45° field of view:
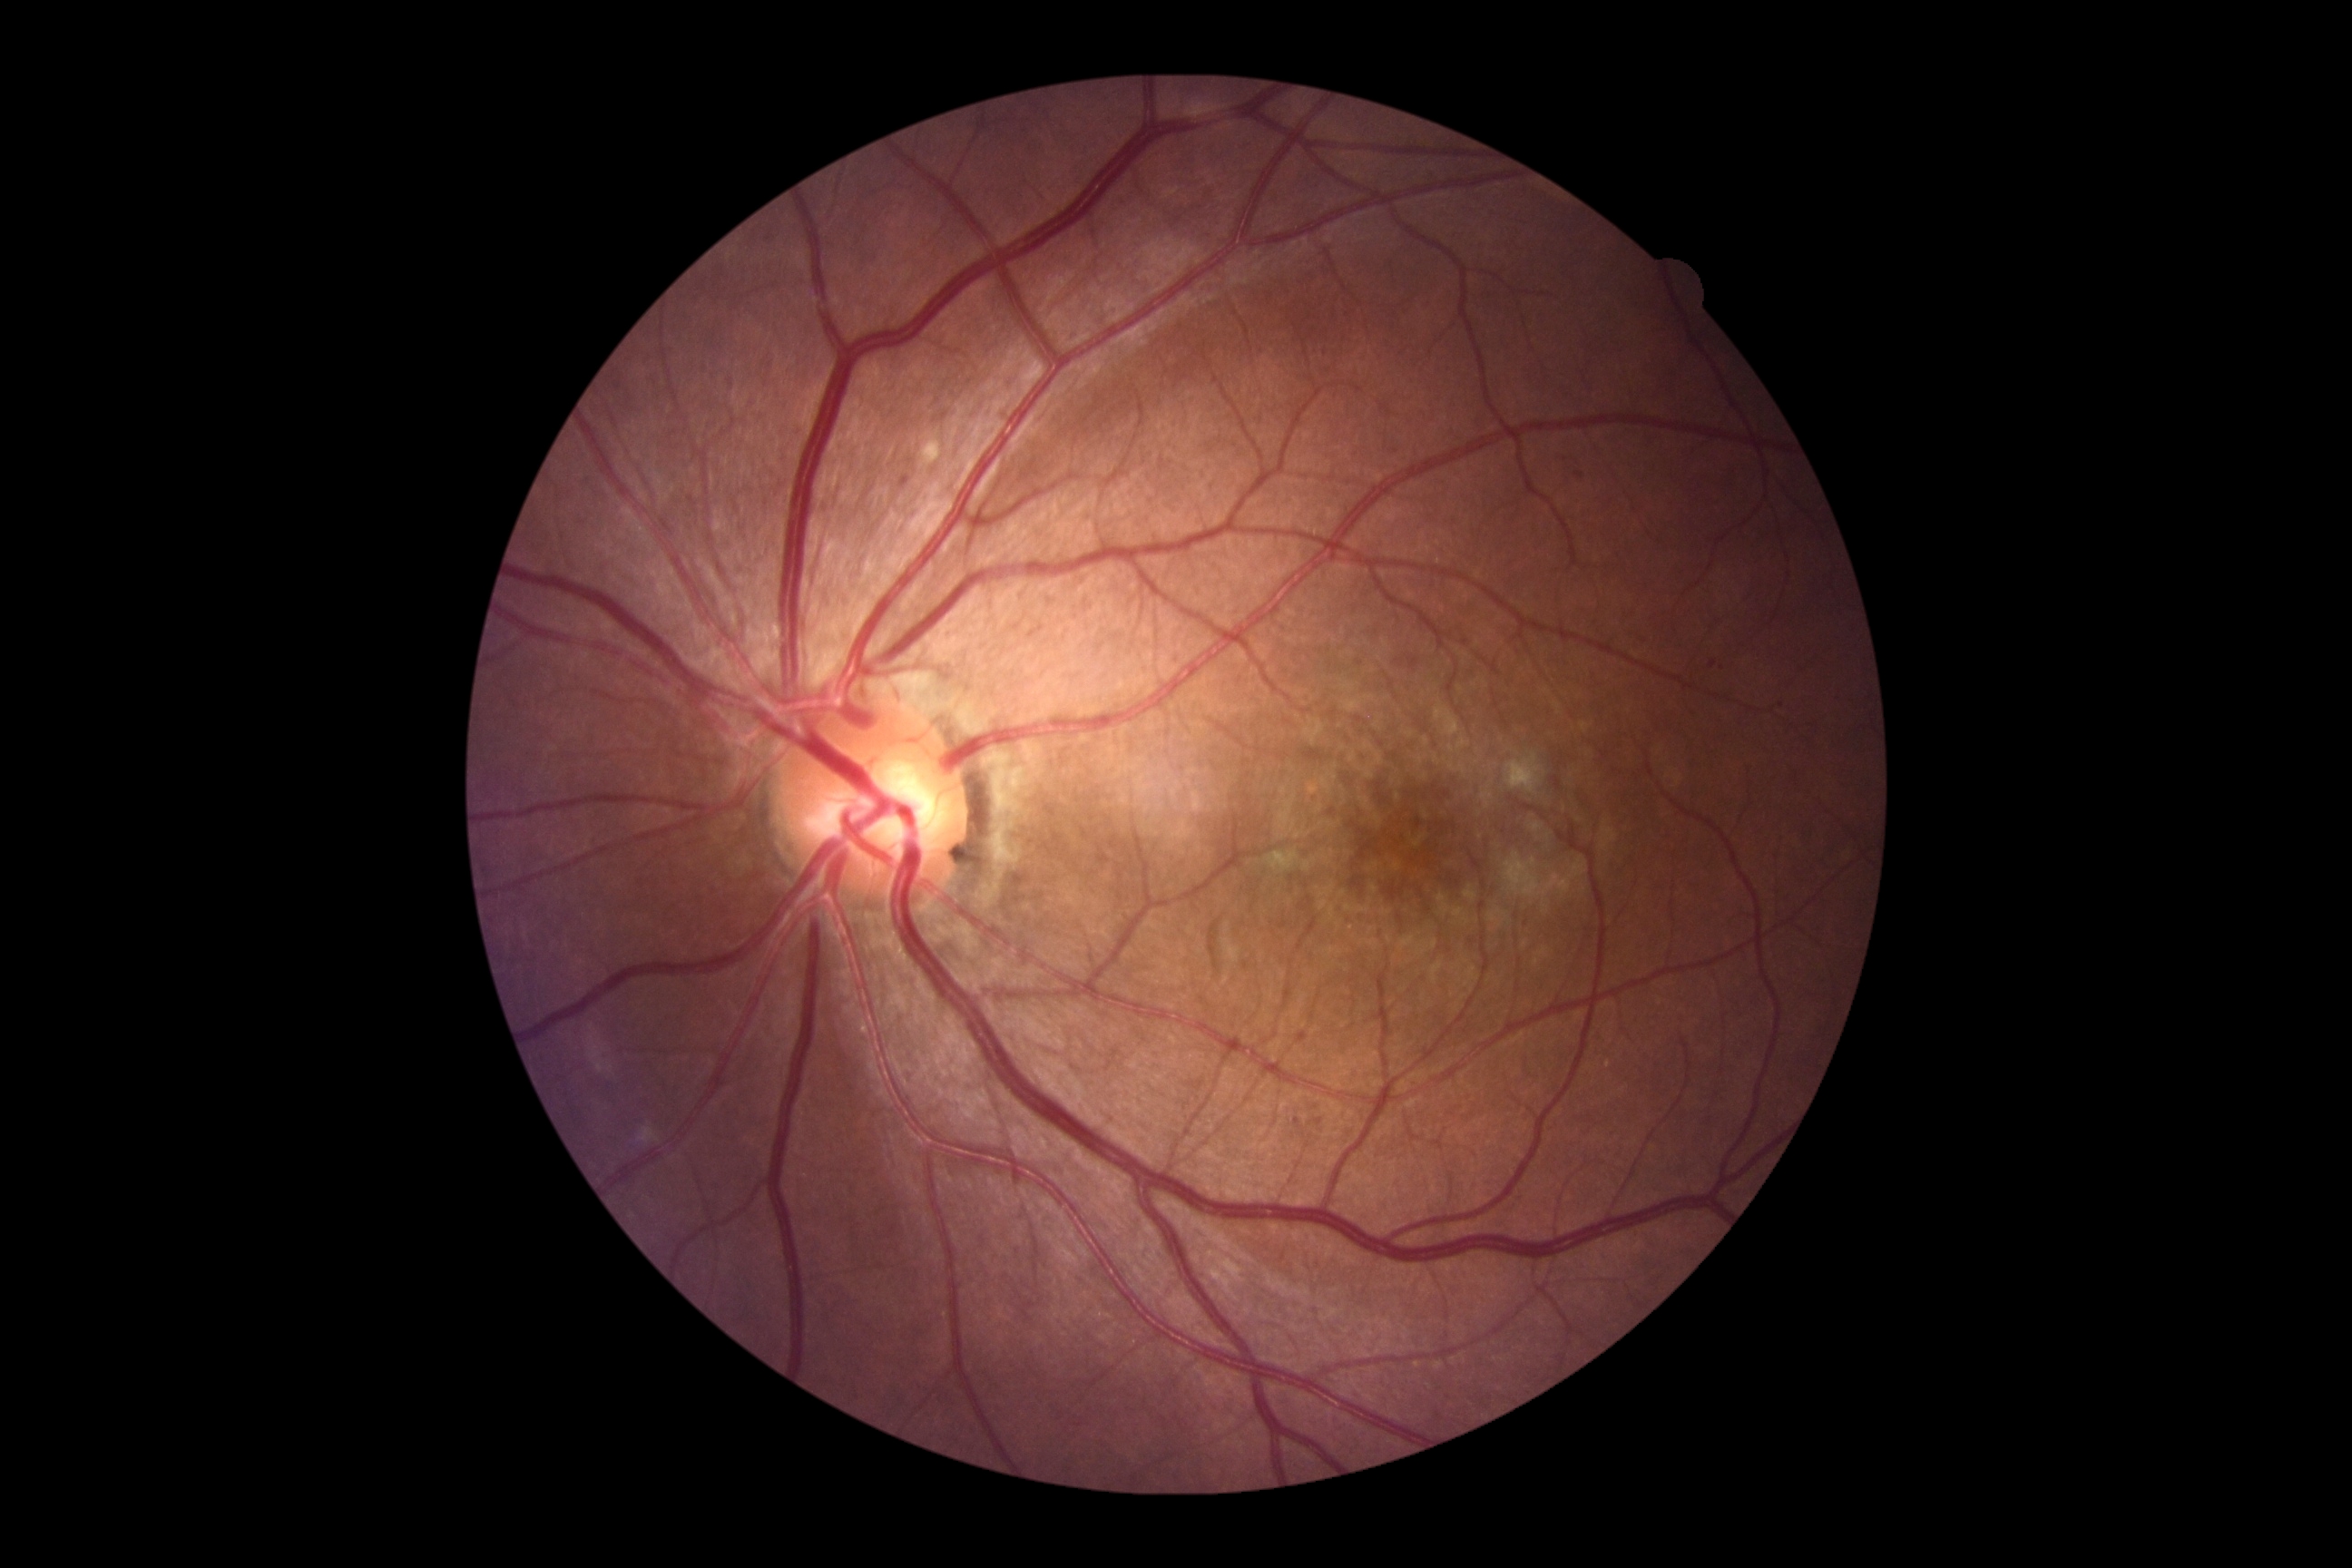 Diabetic retinopathy grade is 2 (moderate NPDR).